Nonmydriatic. Posterior pole color fundus photograph. 848 by 848 pixels
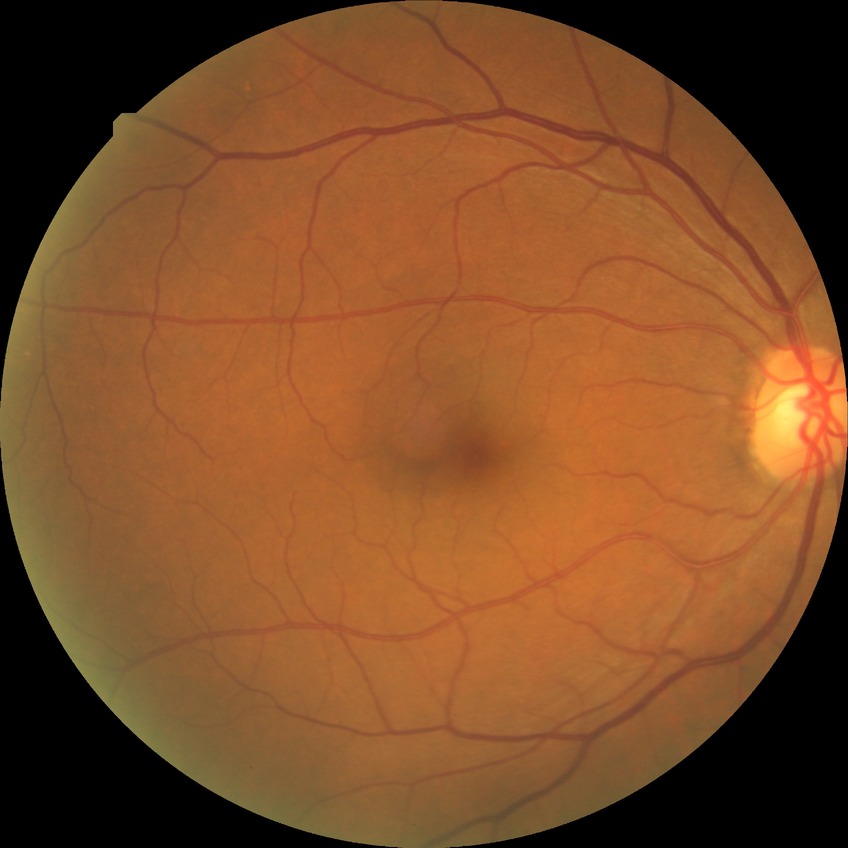

modified Davis grading = no diabetic retinopathy.